45-degree field of view · no pharmacologic dilation · fundus photo · 848x848
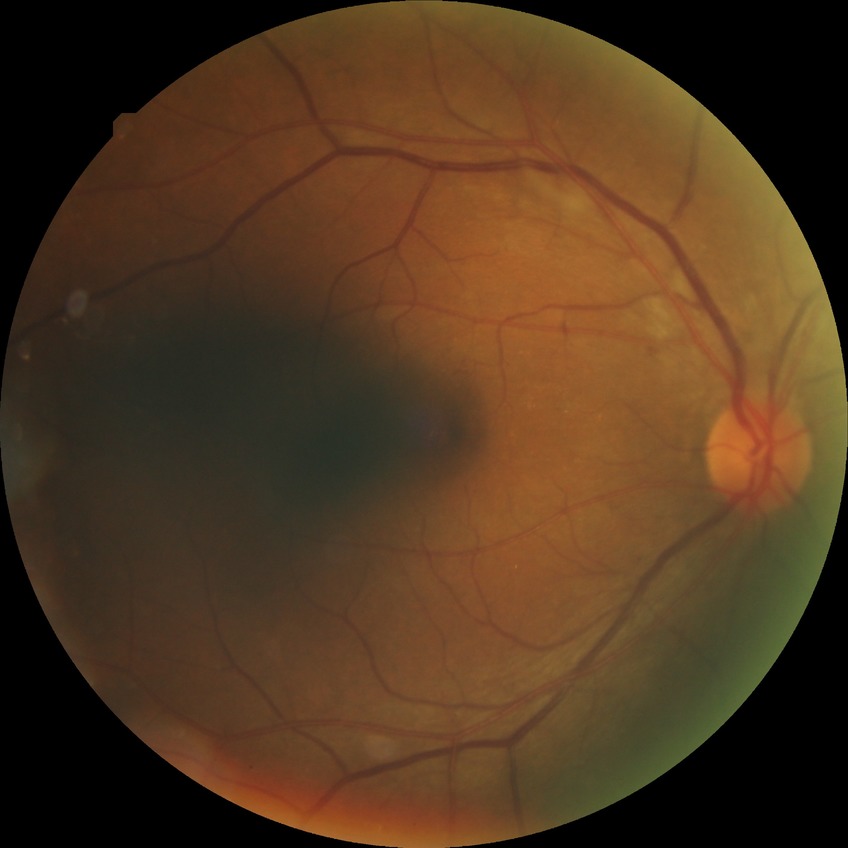
diabetic retinopathy (DR): NDR (no diabetic retinopathy).